CFP · 1380 by 1382 pixels · FOV: 45 degrees:
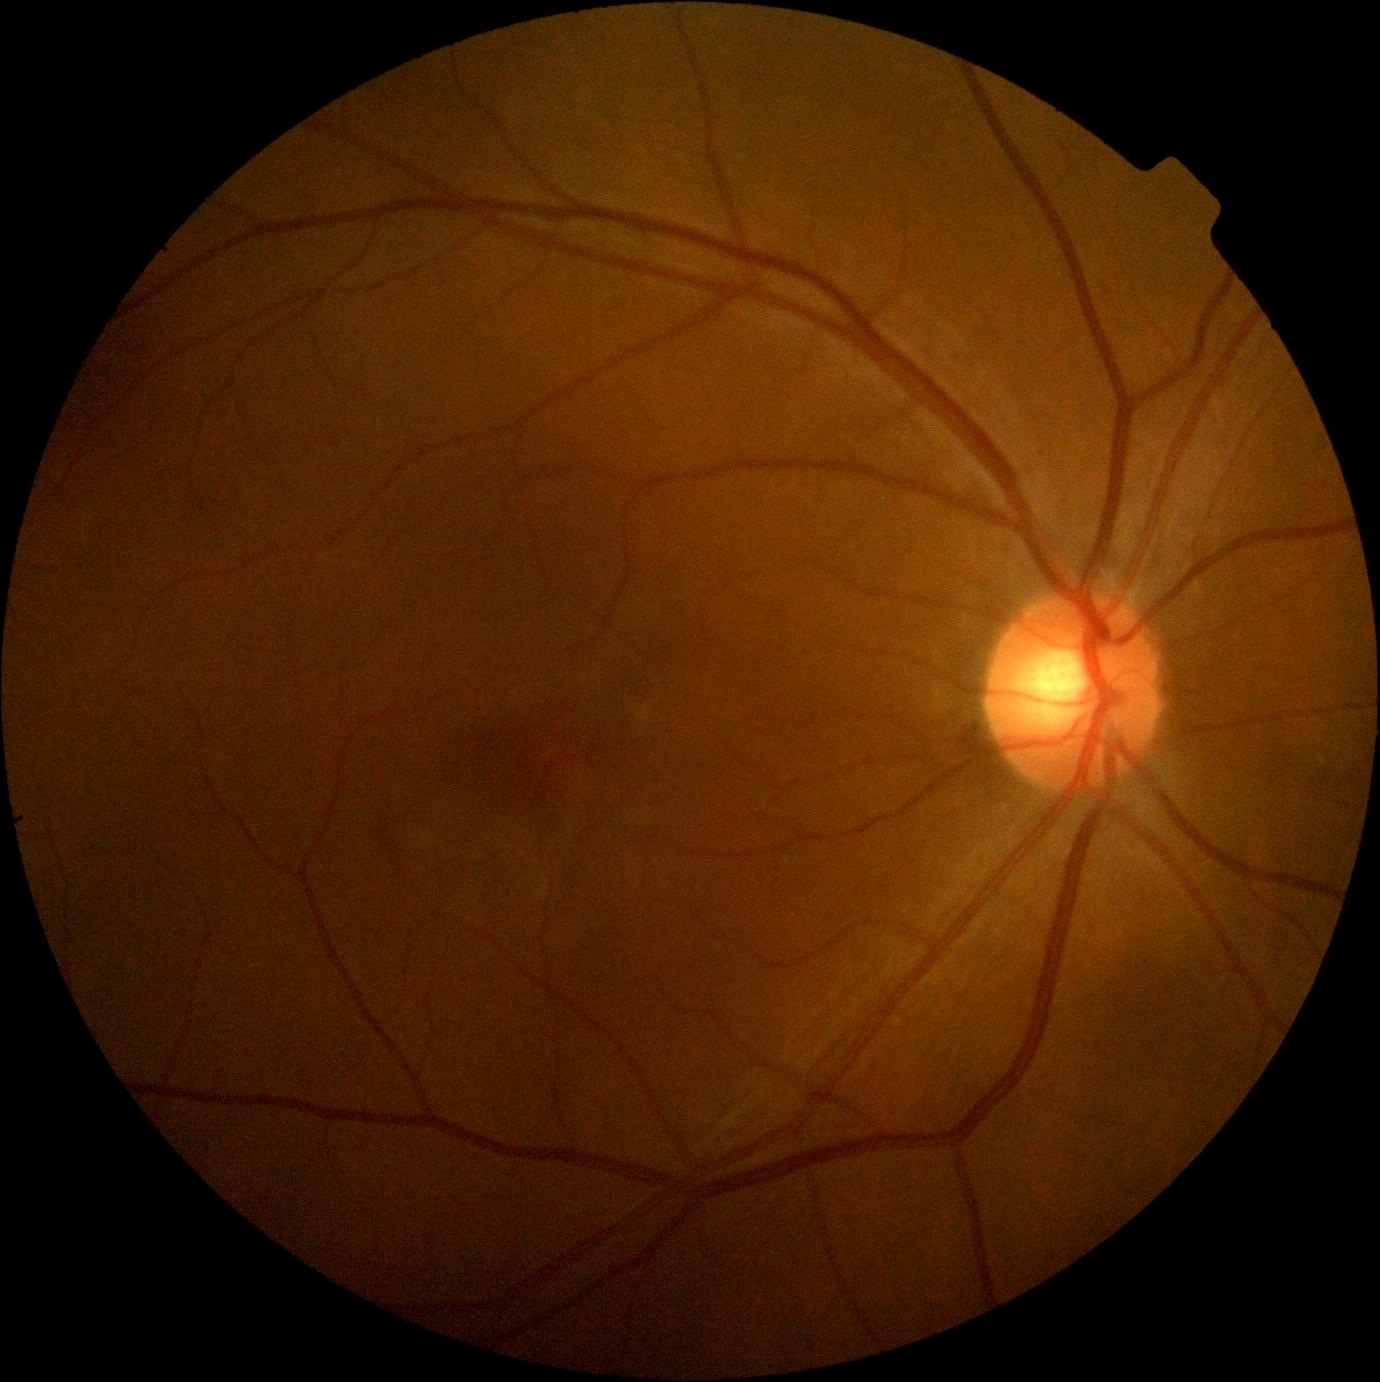

Diabetic retinopathy grade: 0 — no visible signs of diabetic retinopathy.